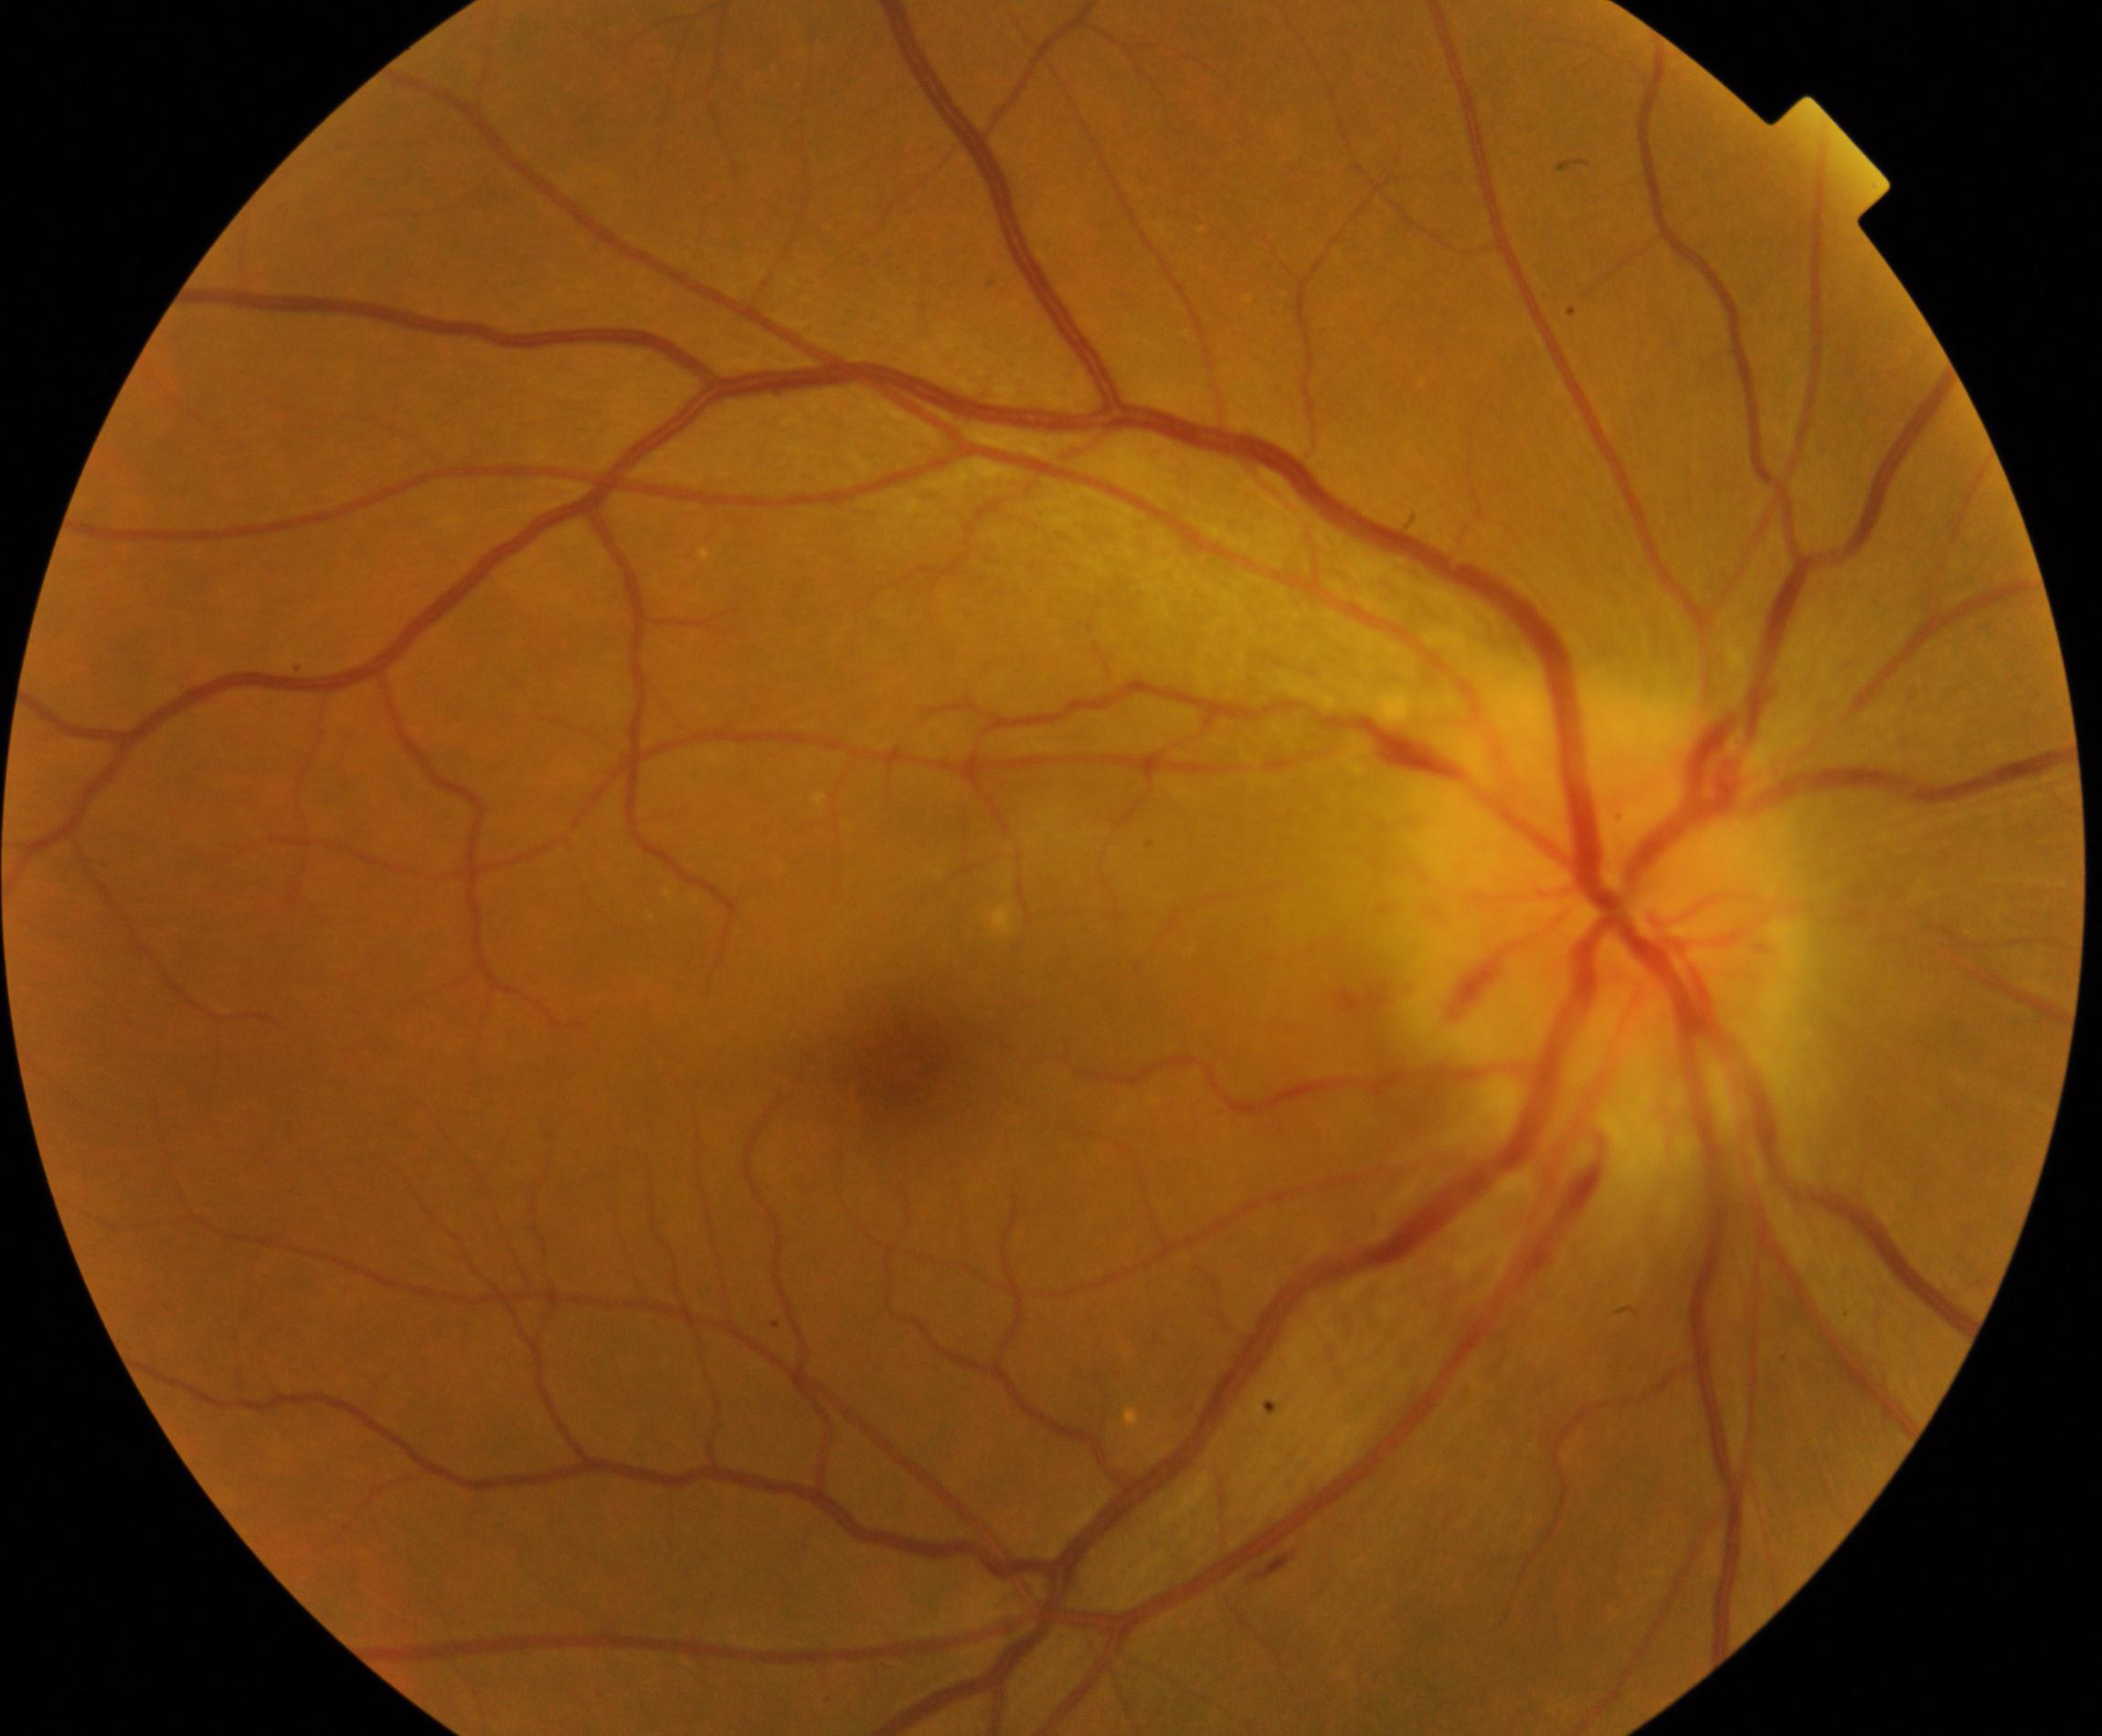
Findings: disc swelling and elevation. Defined by disc hyperemia and elevation with indistinct disc margins, sometimes with peripapillary flame hemorrhages and cotton-wool spots.